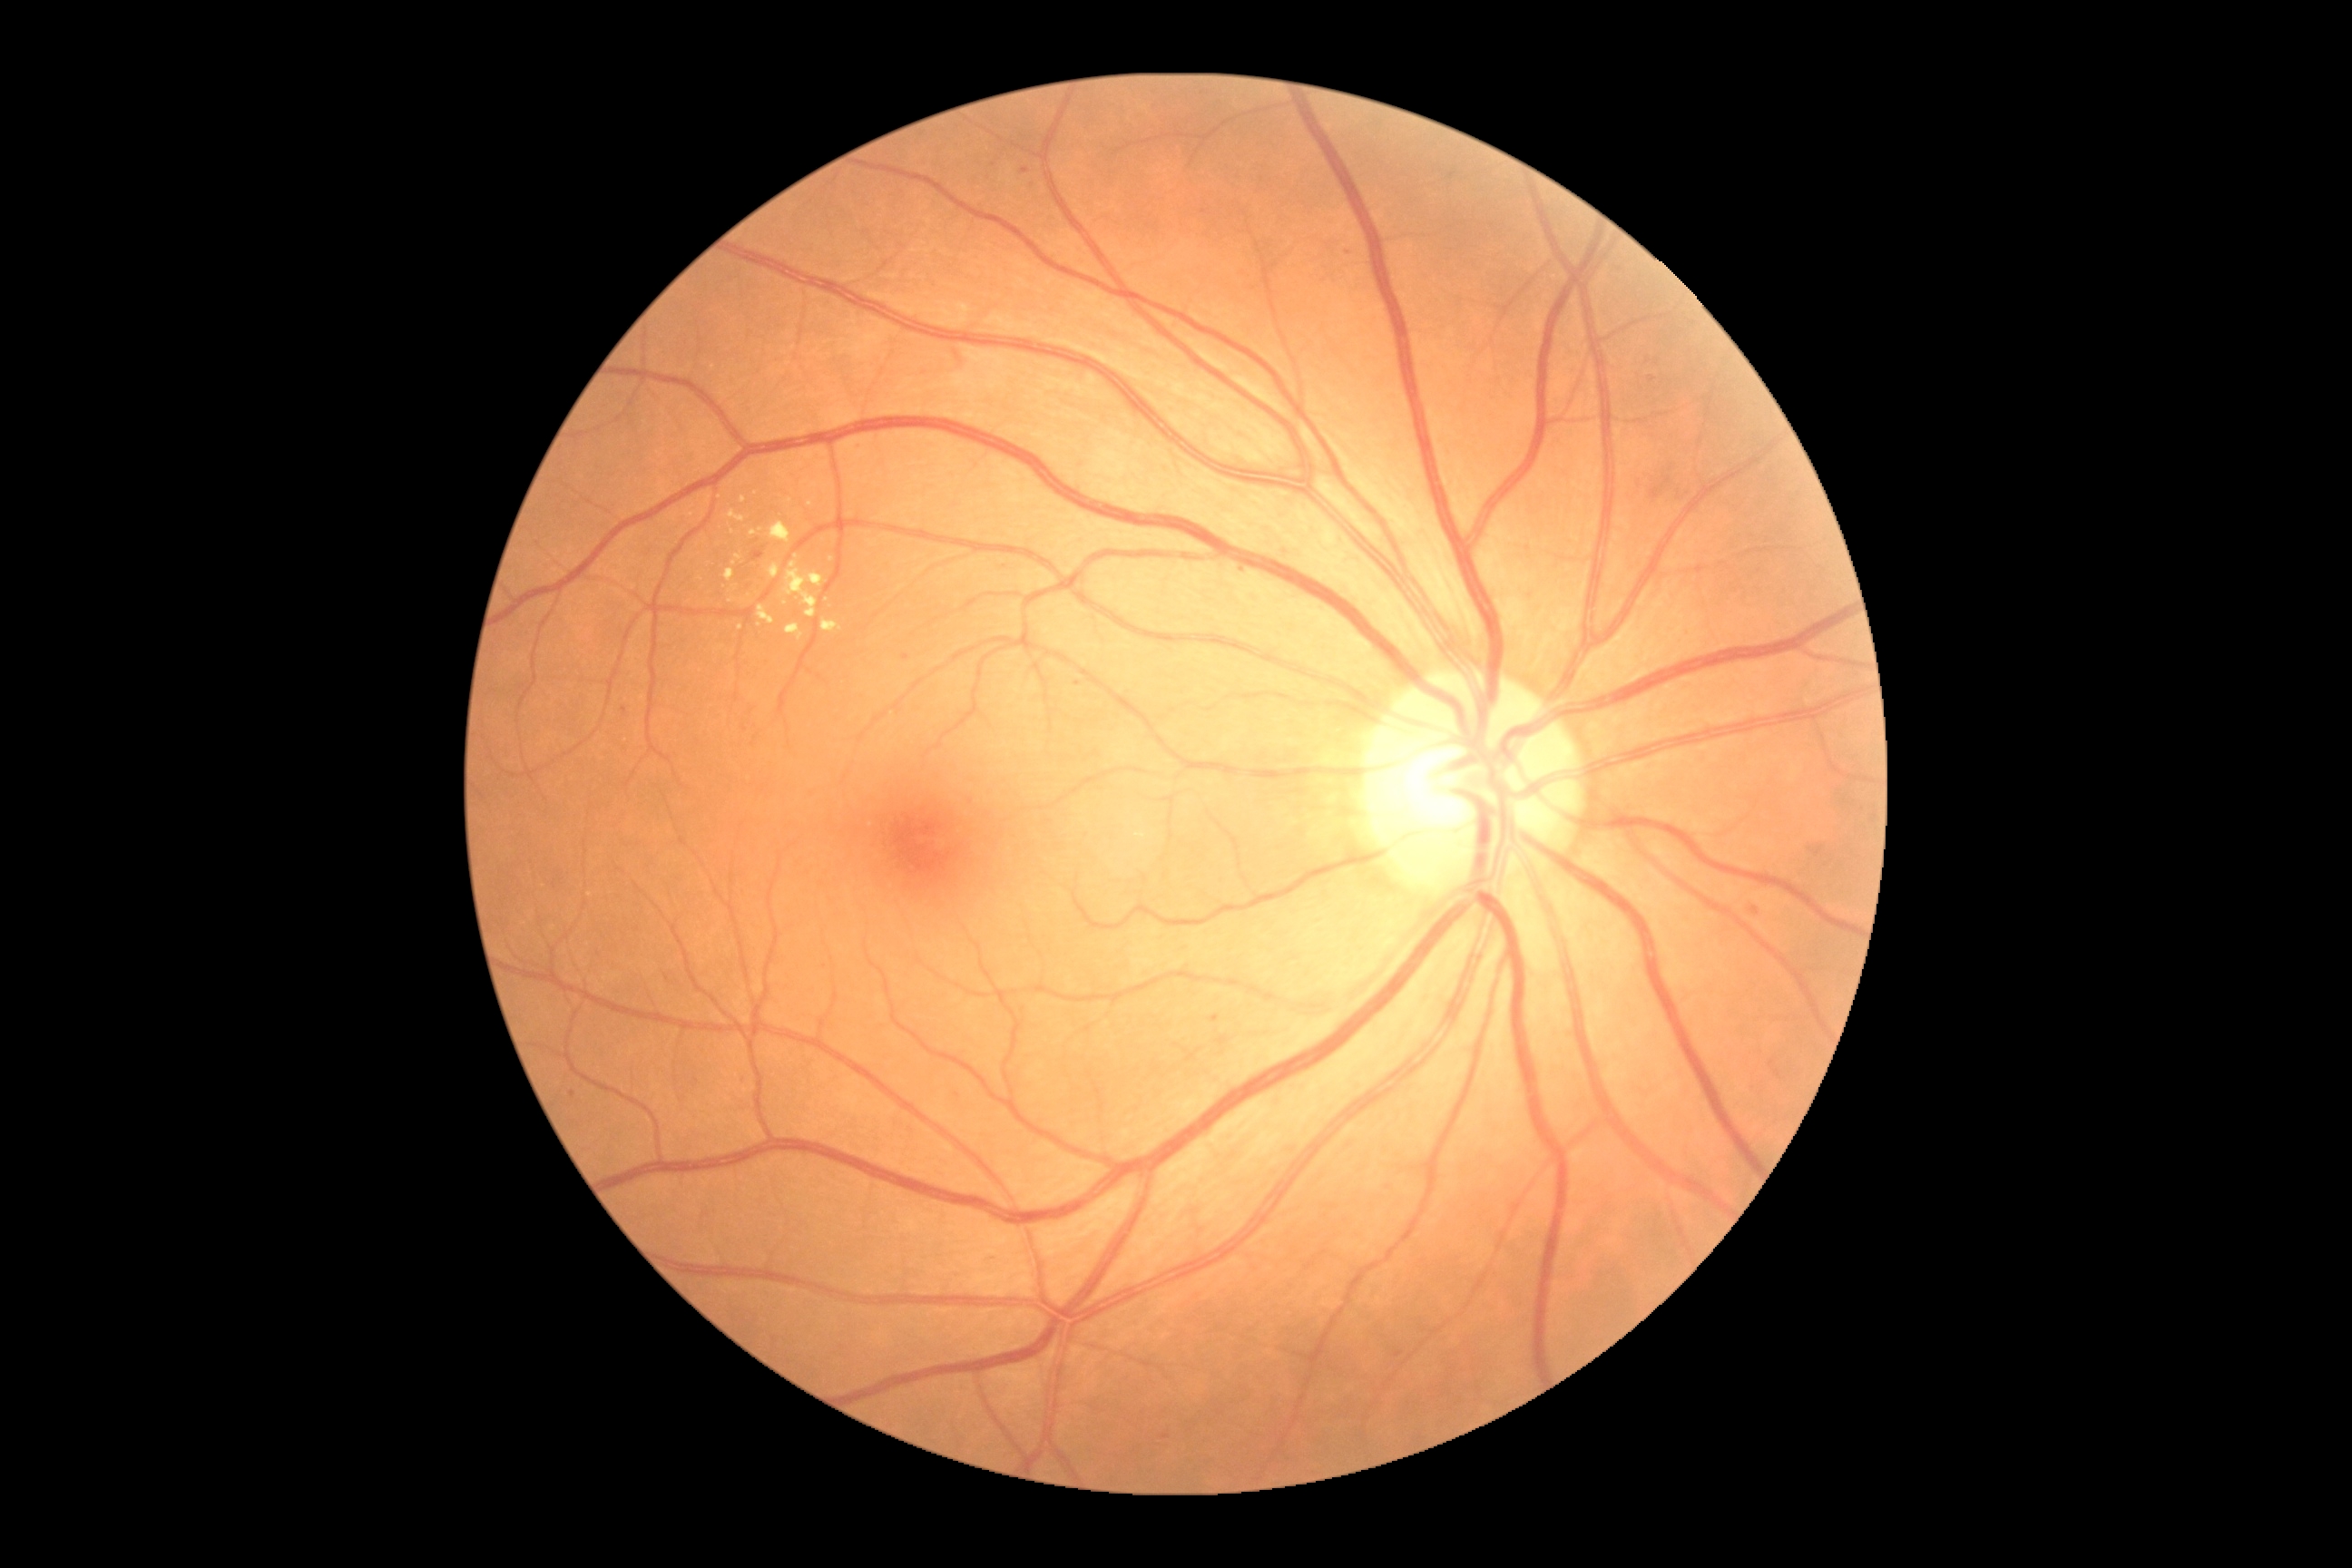 Diabetic retinopathy grade: moderate non-proliferative diabetic retinopathy (2)
Selected lesions:
hard exudates (subset): l=723, t=569, r=736, b=587 | l=741, t=496, r=747, b=504 | l=770, t=522, r=790, b=544 | l=769, t=564, r=781, b=580 | l=785, t=623, r=803, b=642
Additional small hard exudates near 811/504 | 738/557 | 797/557 | 790/501 | 734/563 | 832/560 | 753/491